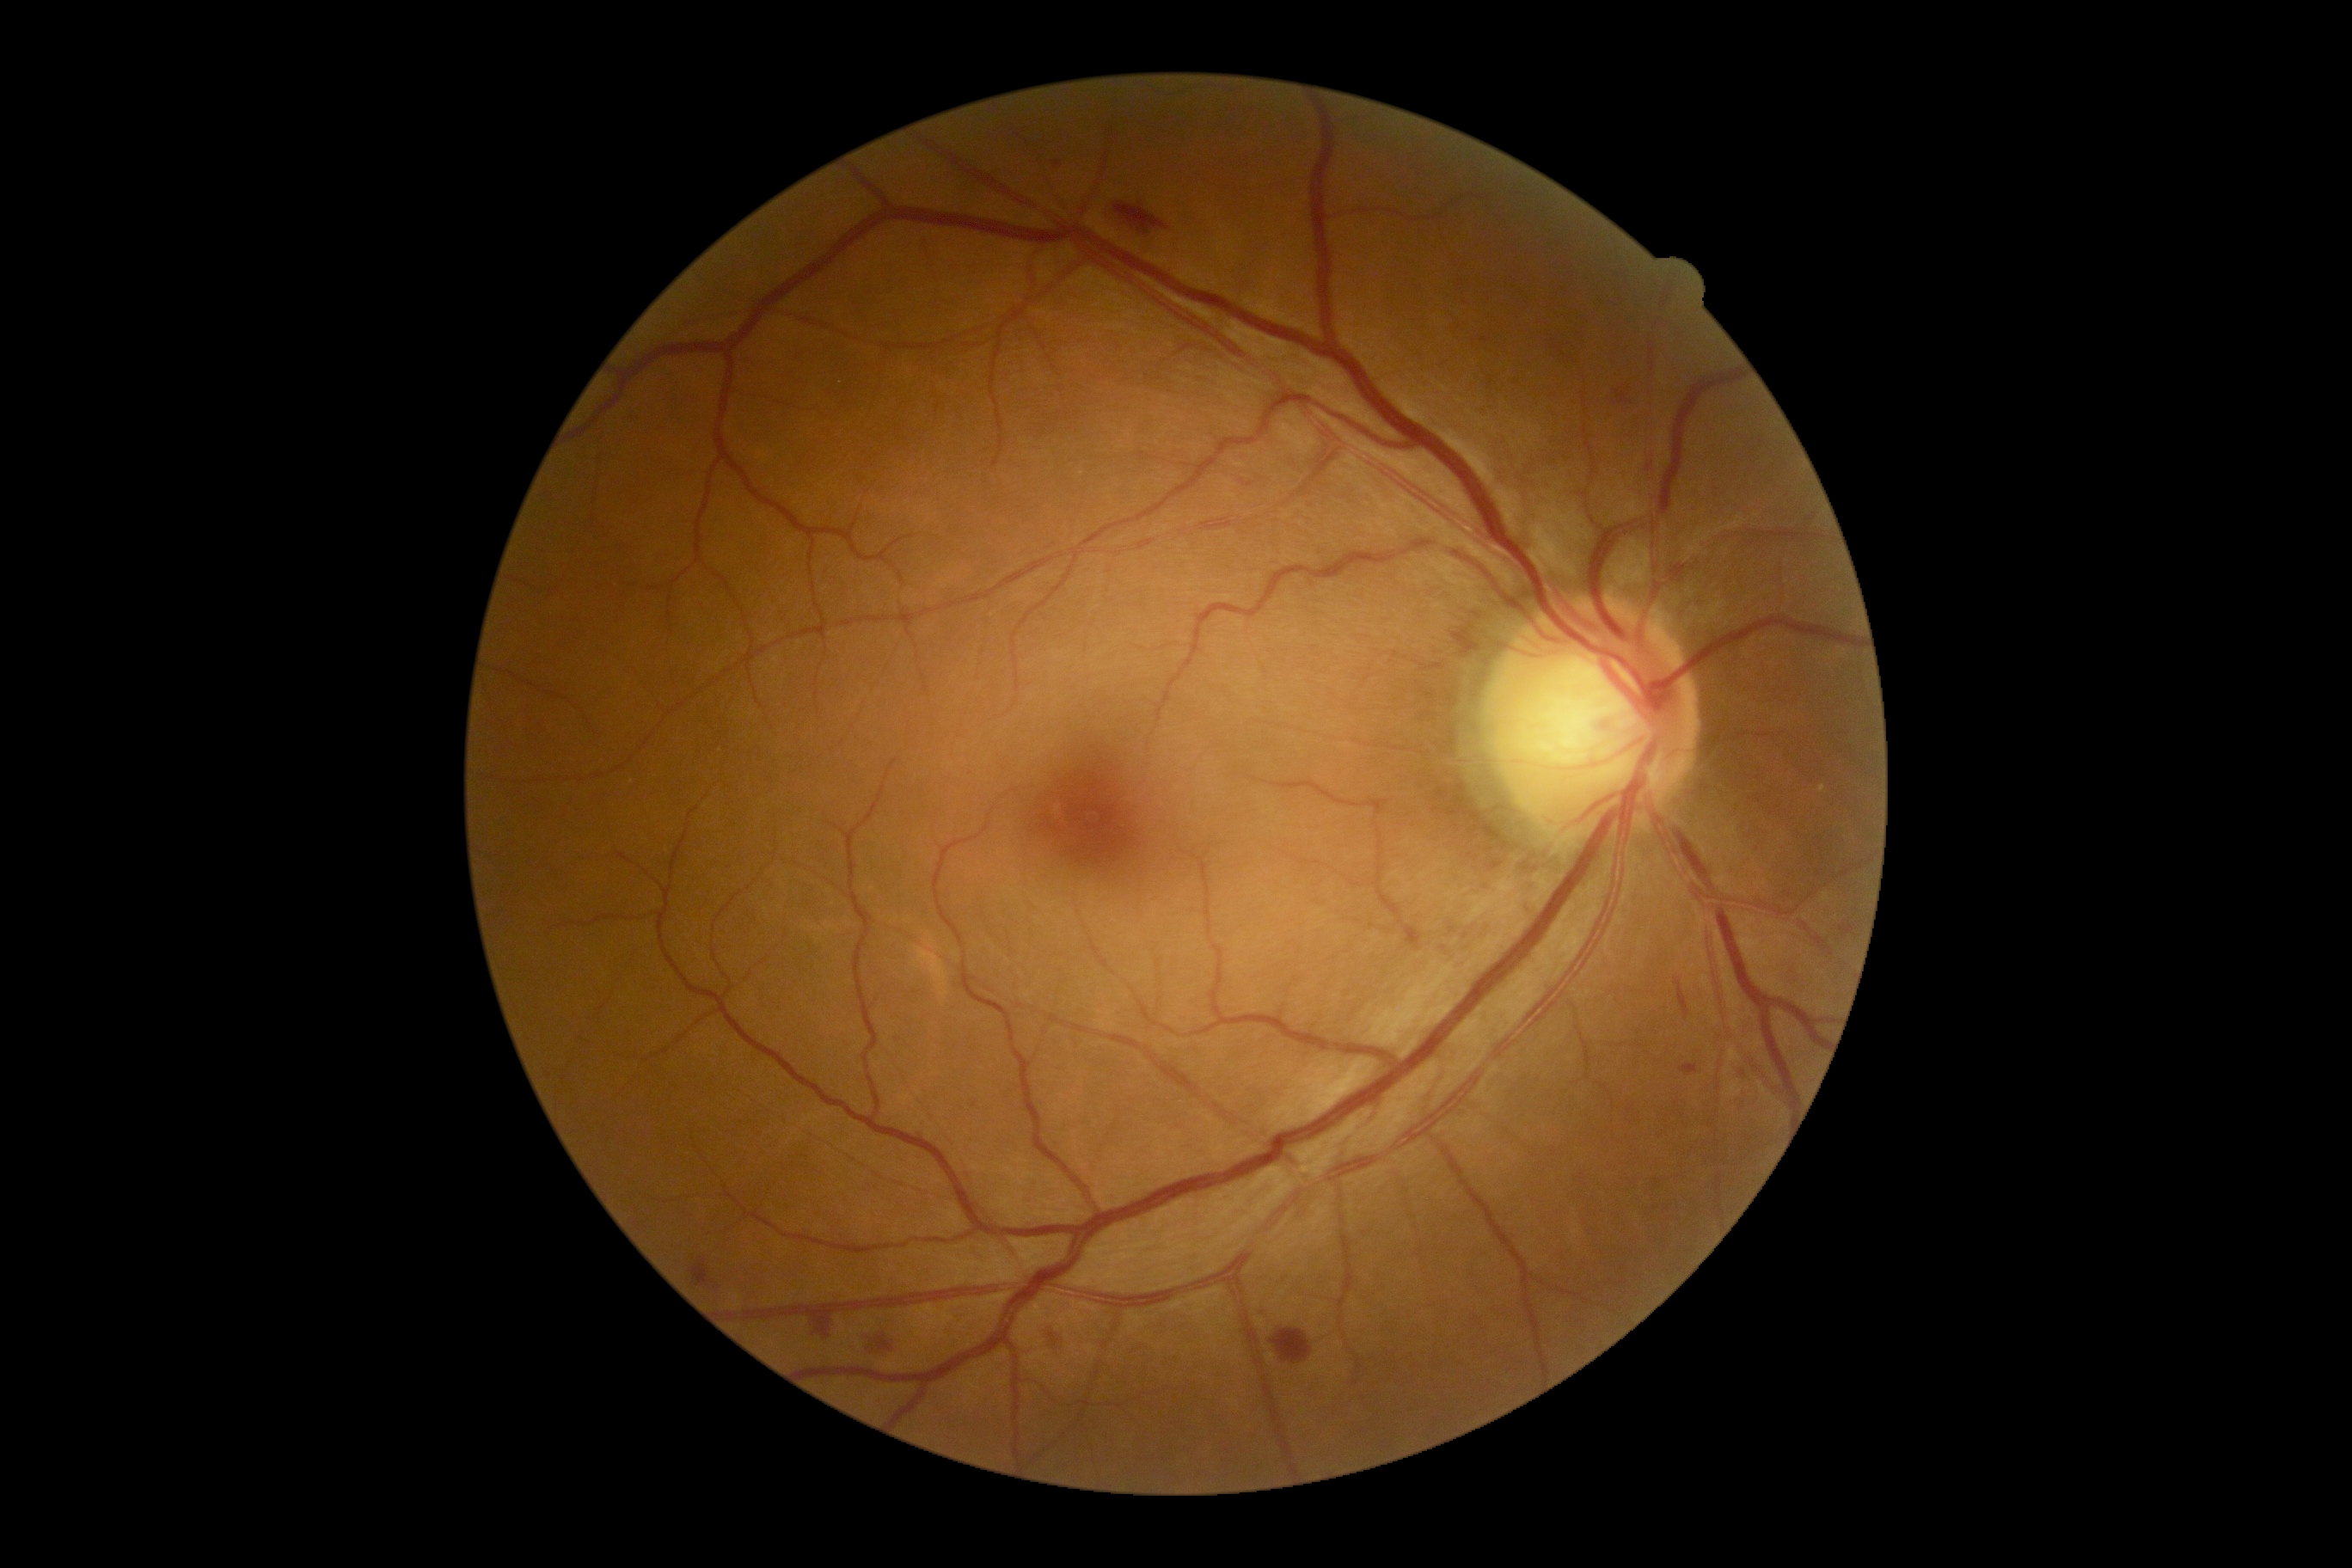

diabetic retinopathy grade: 2/4